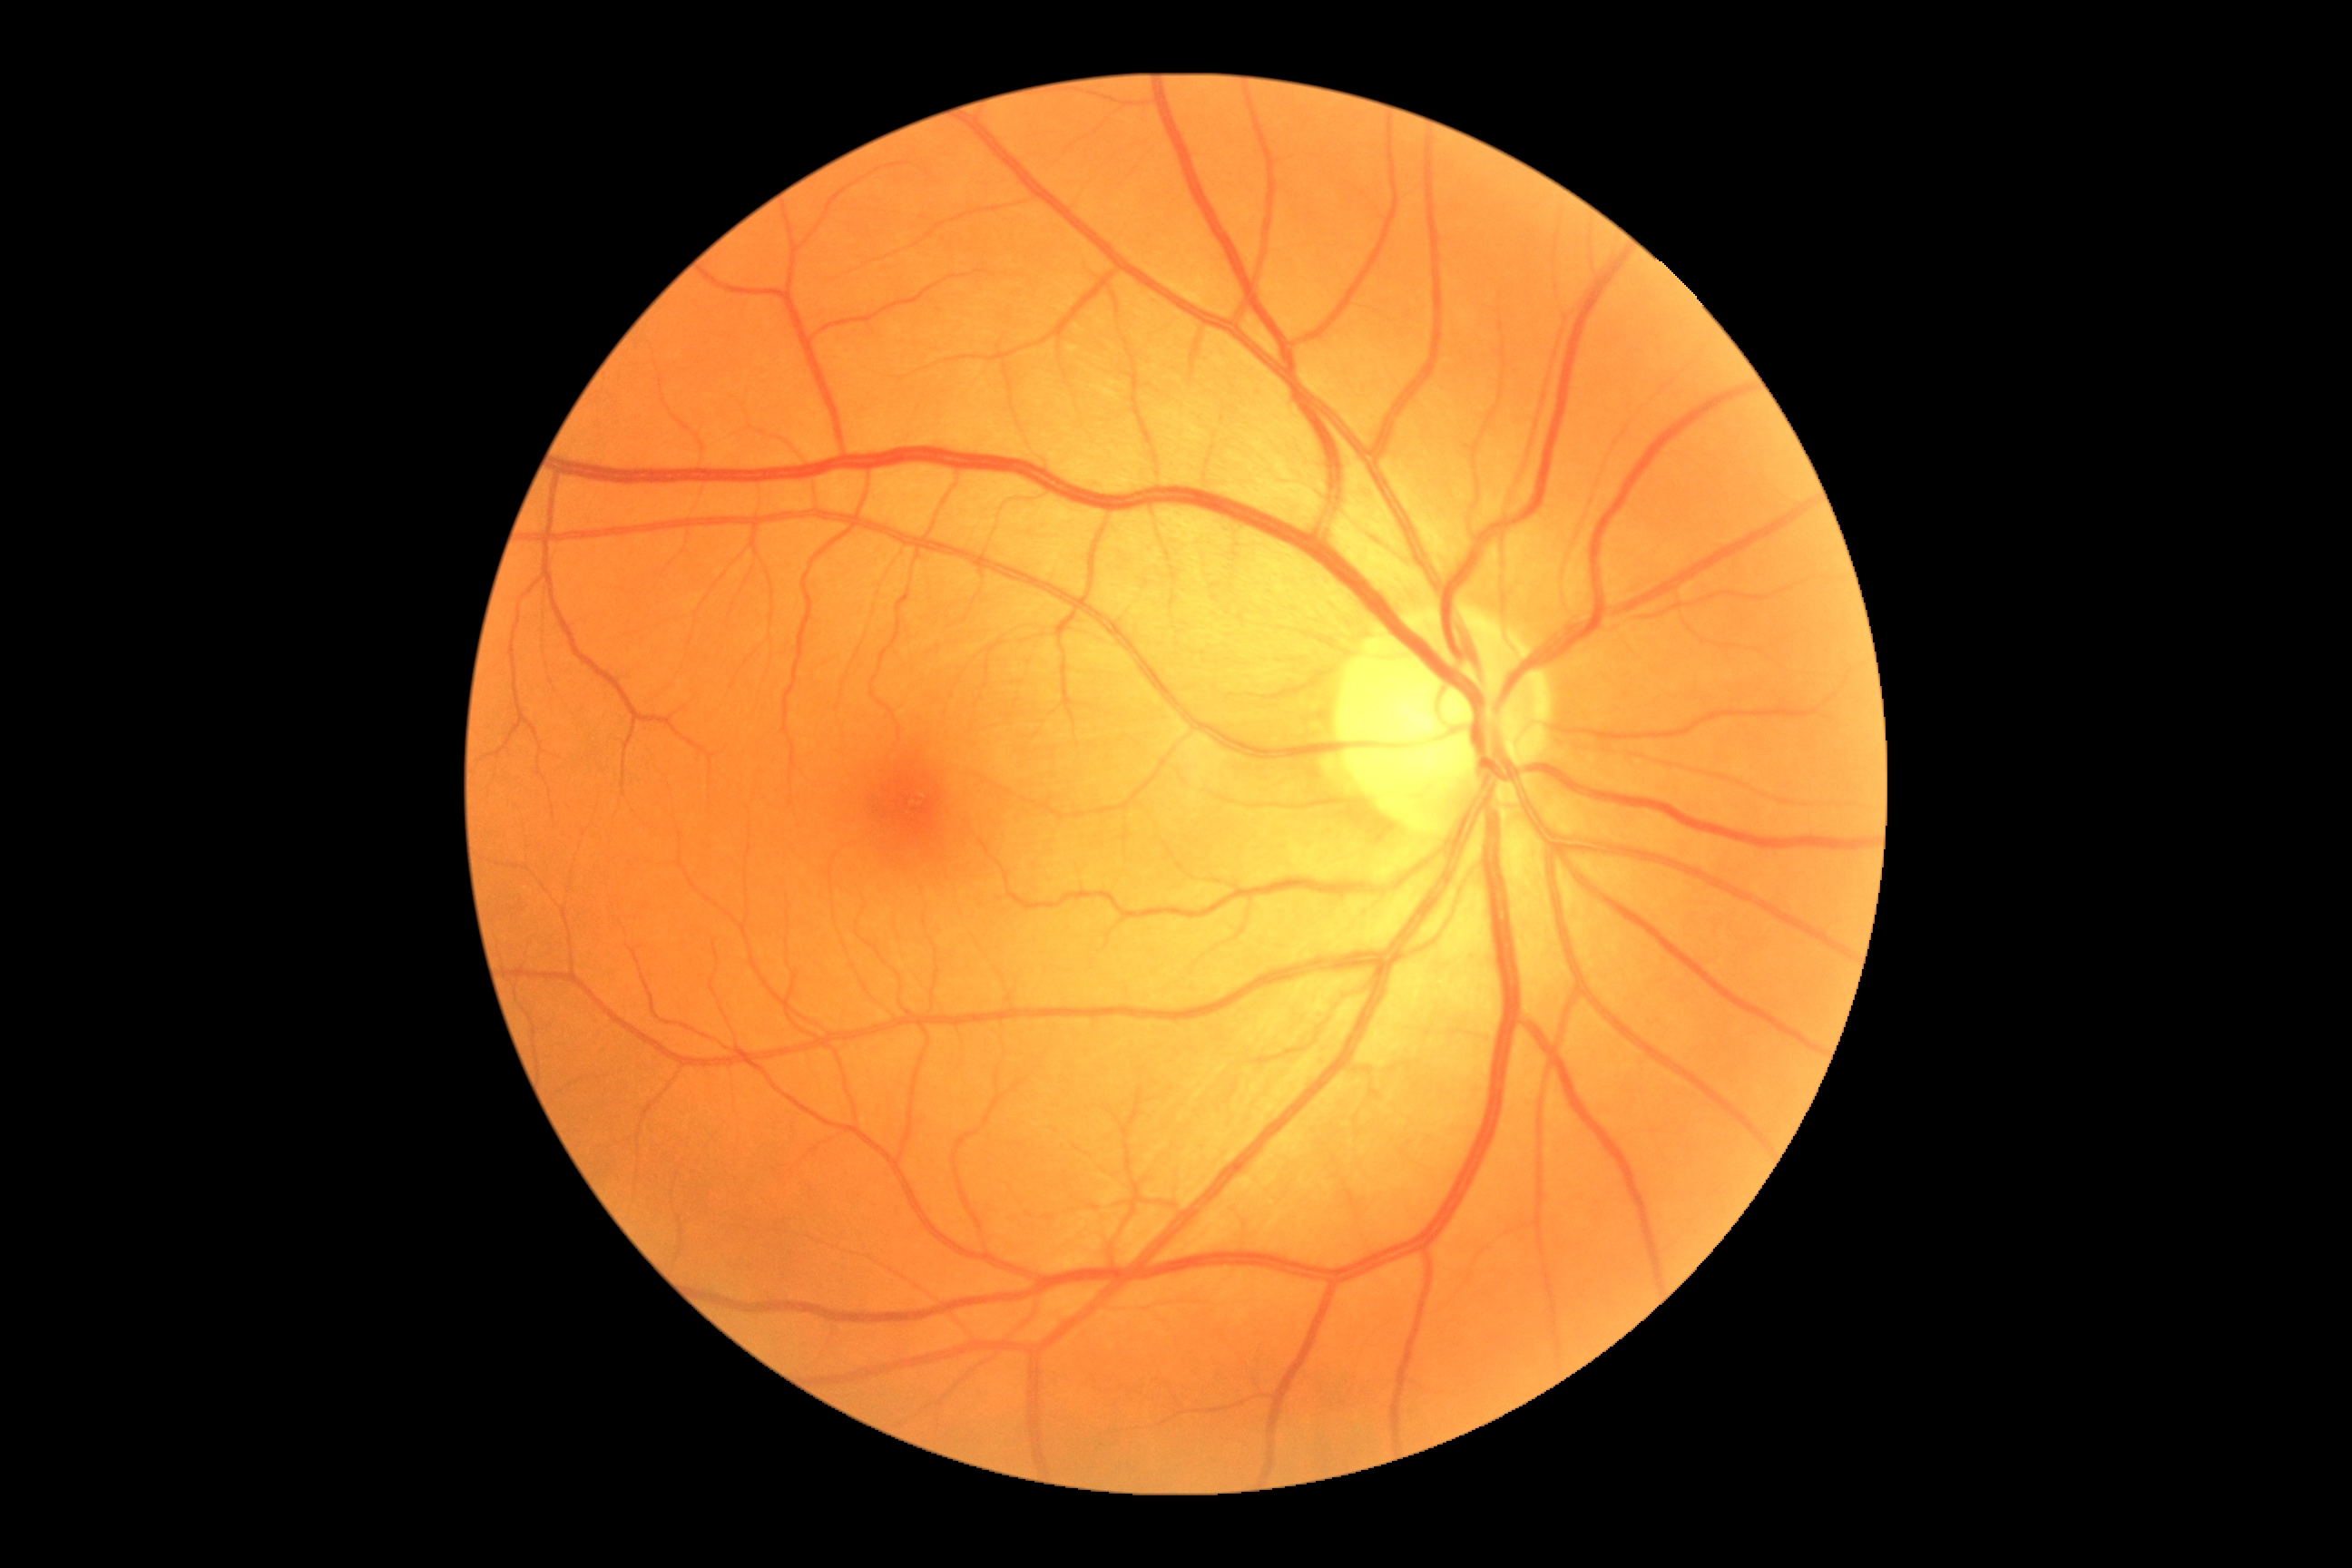
DR stage: grade 0 (no apparent retinopathy).